1960x1897
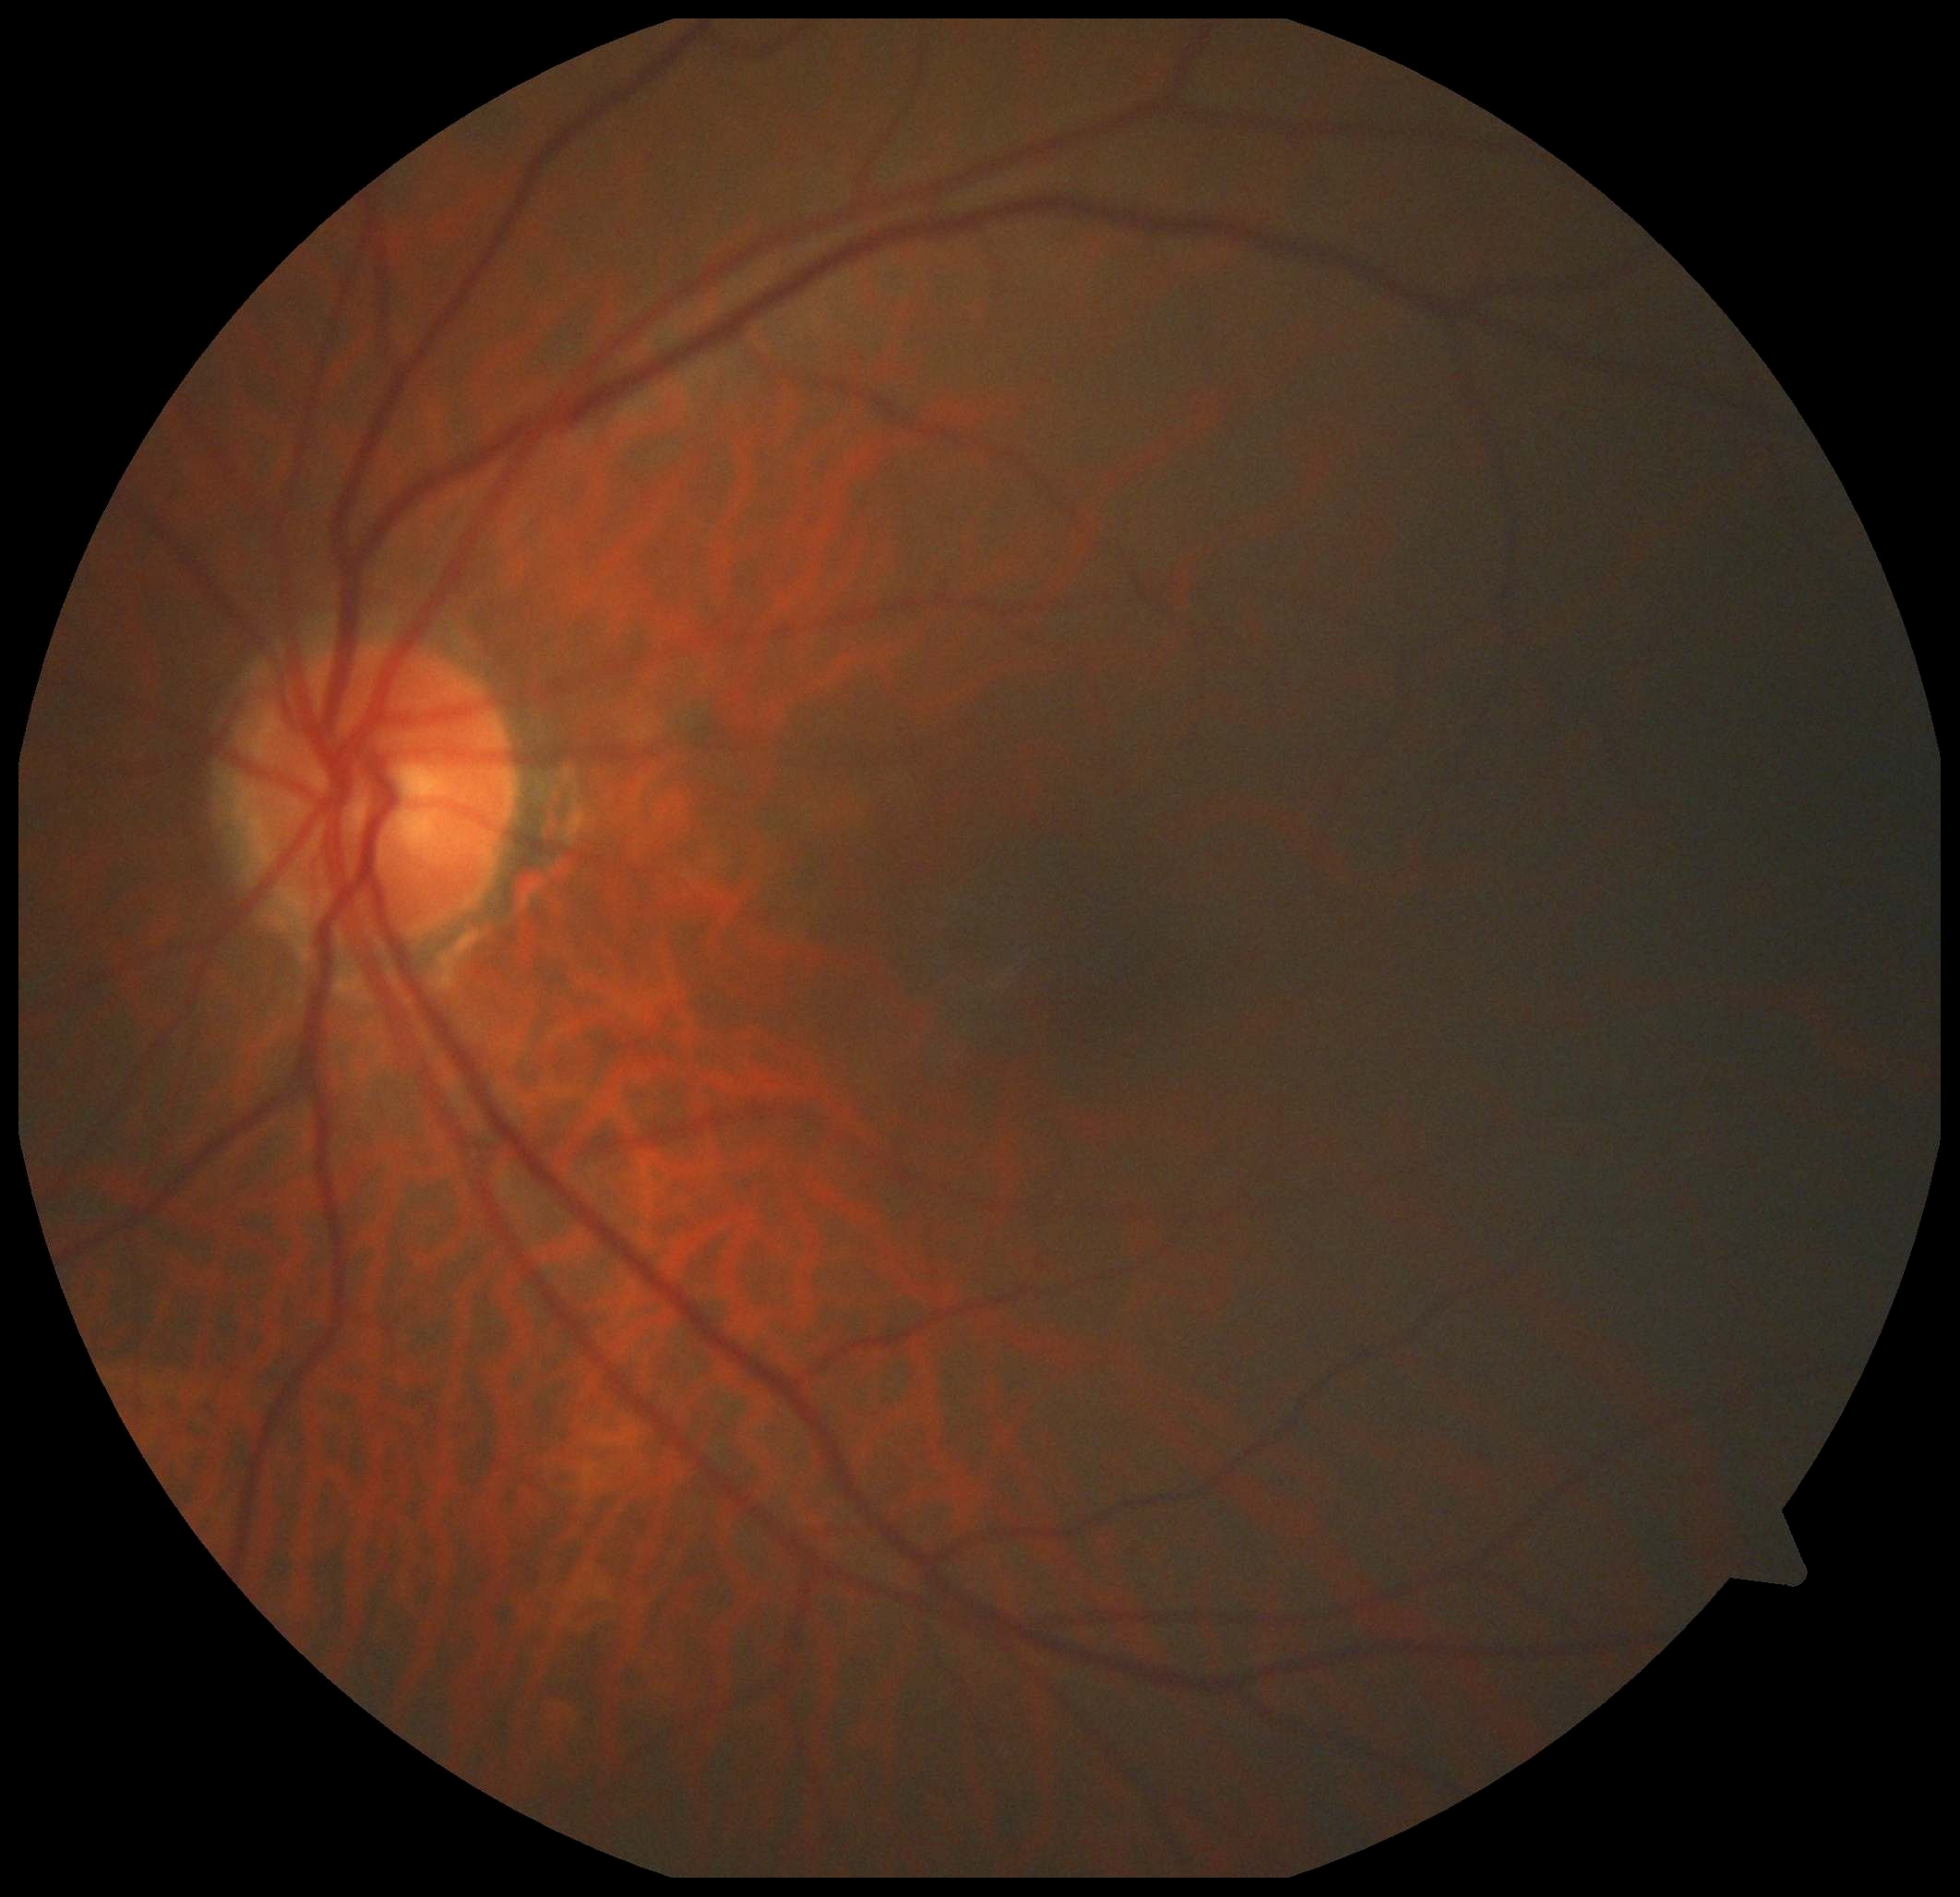
No DR findings. DR severity: grade 0 — no visible signs of diabetic retinopathy.